45-degree field of view, retinal fundus photograph, 2346 by 1568 pixels
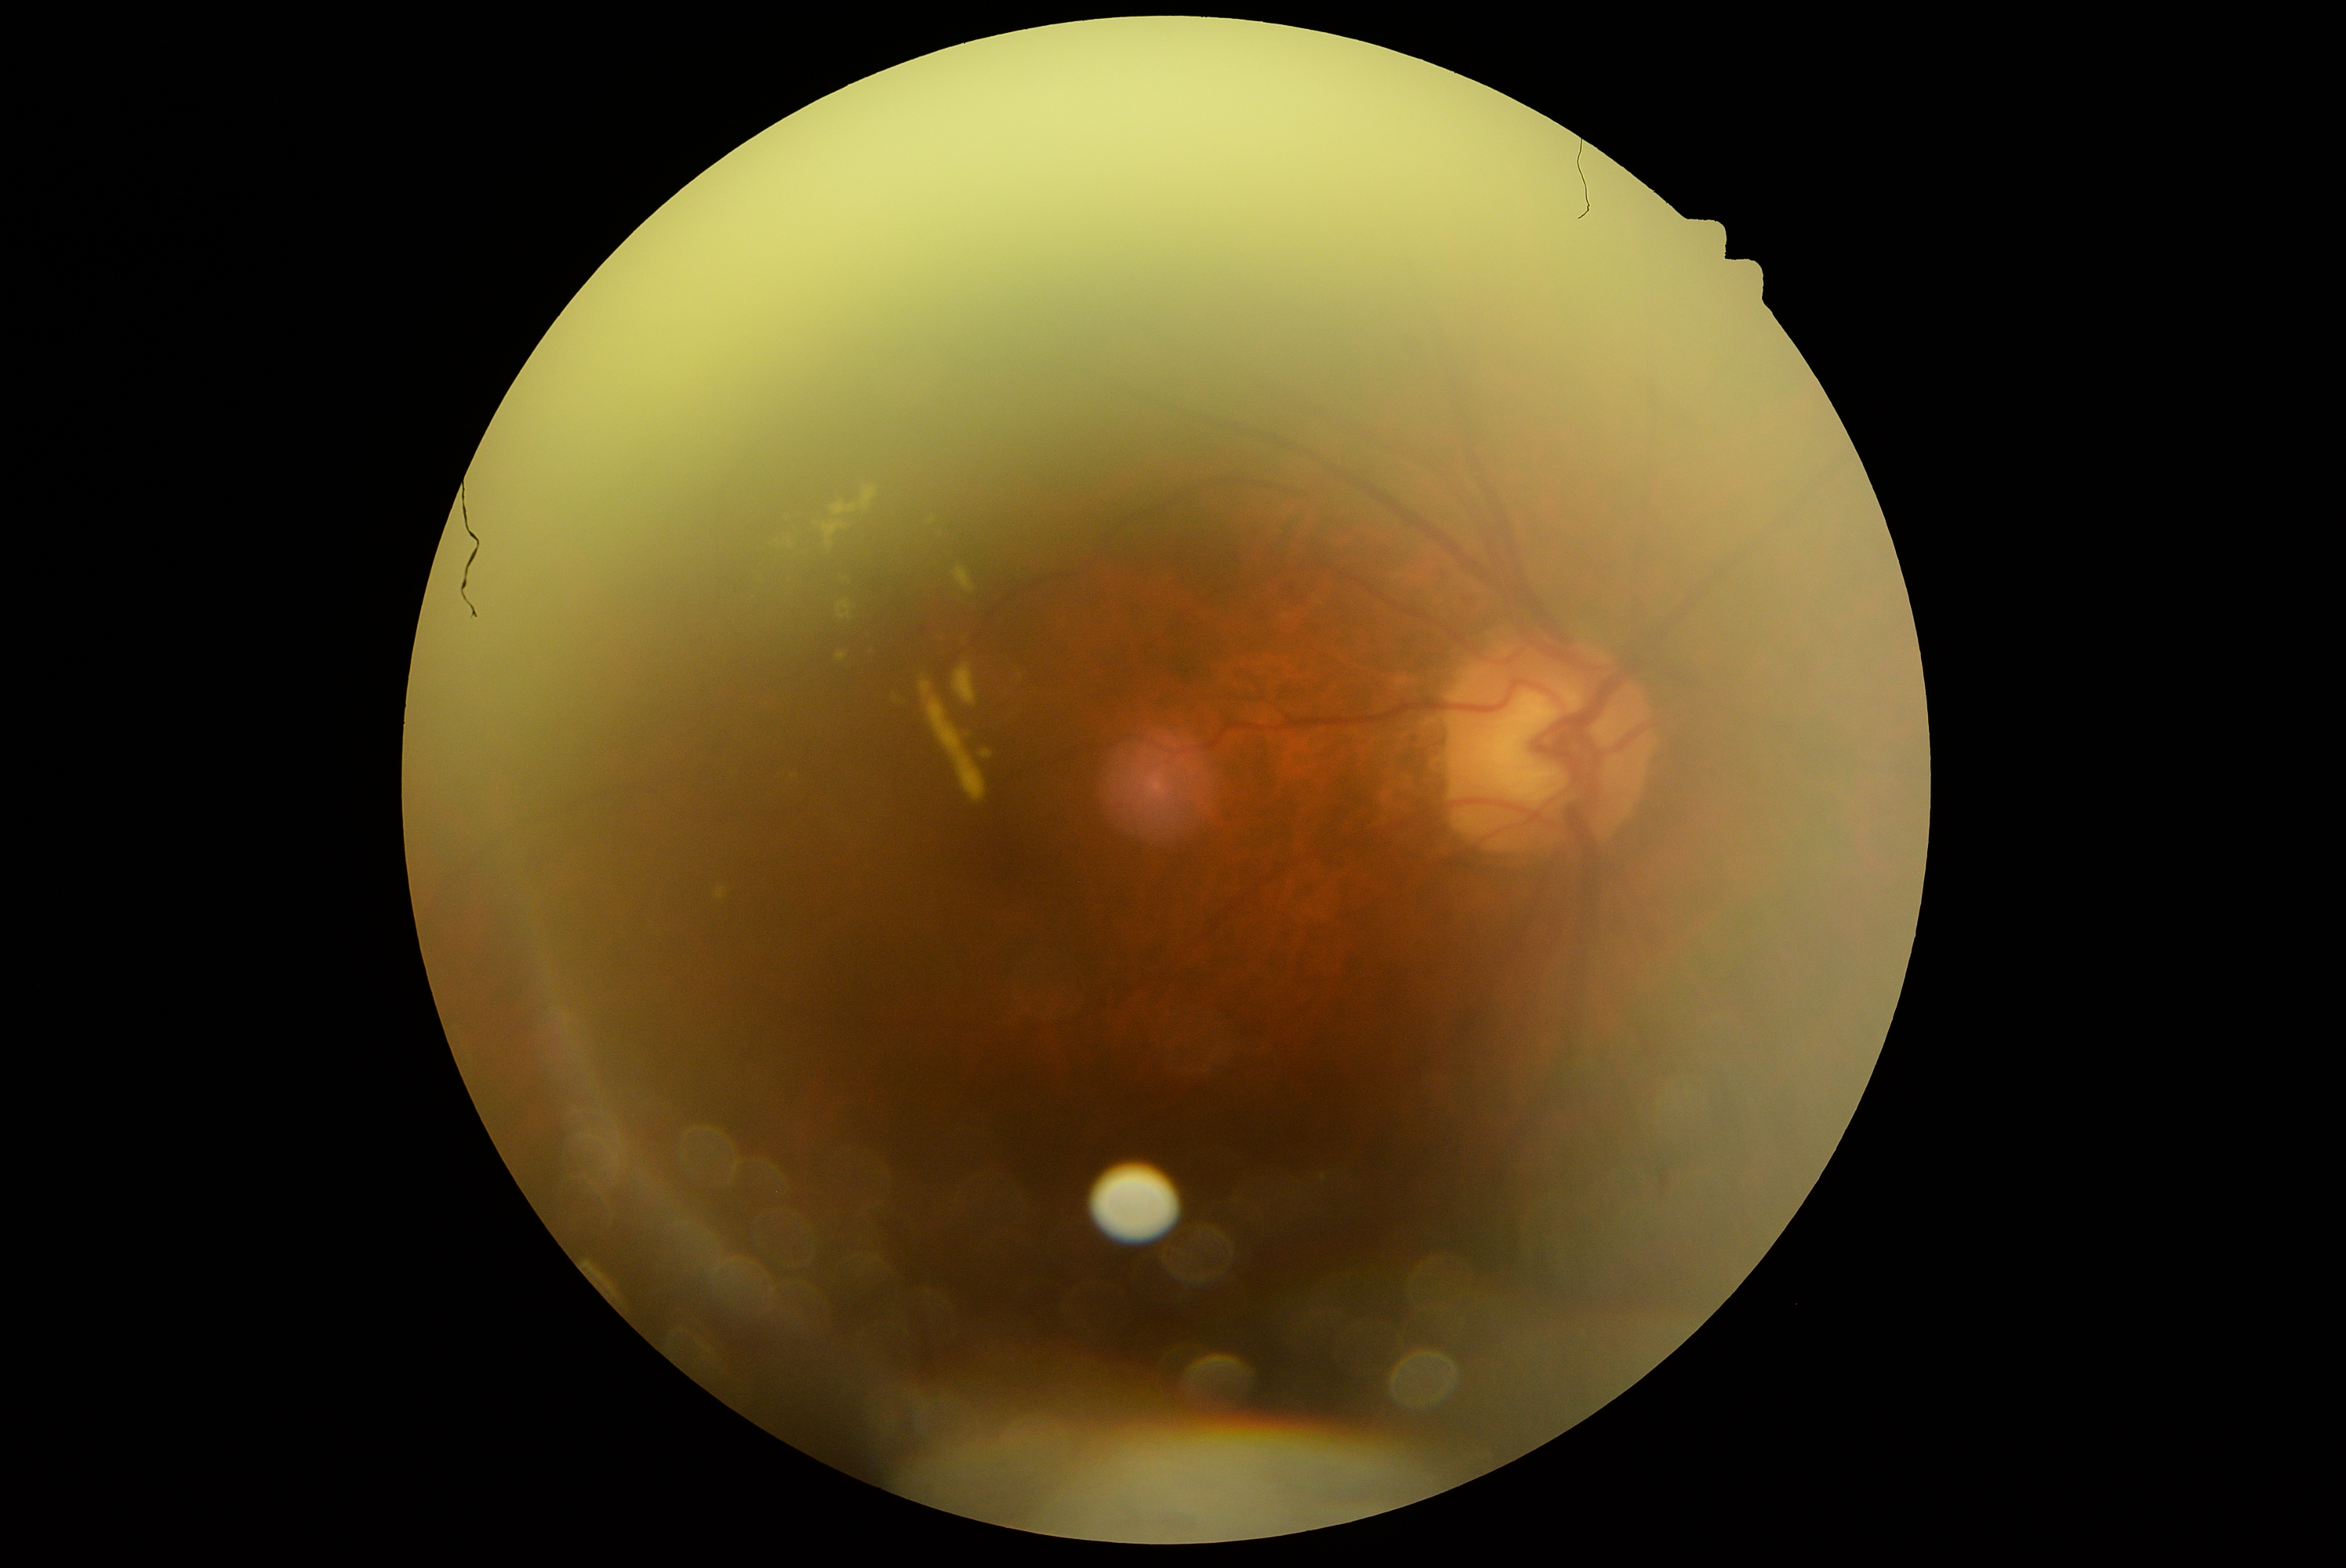 Diabetic retinopathy (DR) is grade 2 — more than just microaneurysms but less than severe NPDR.